Remidio Fundus on Phone.
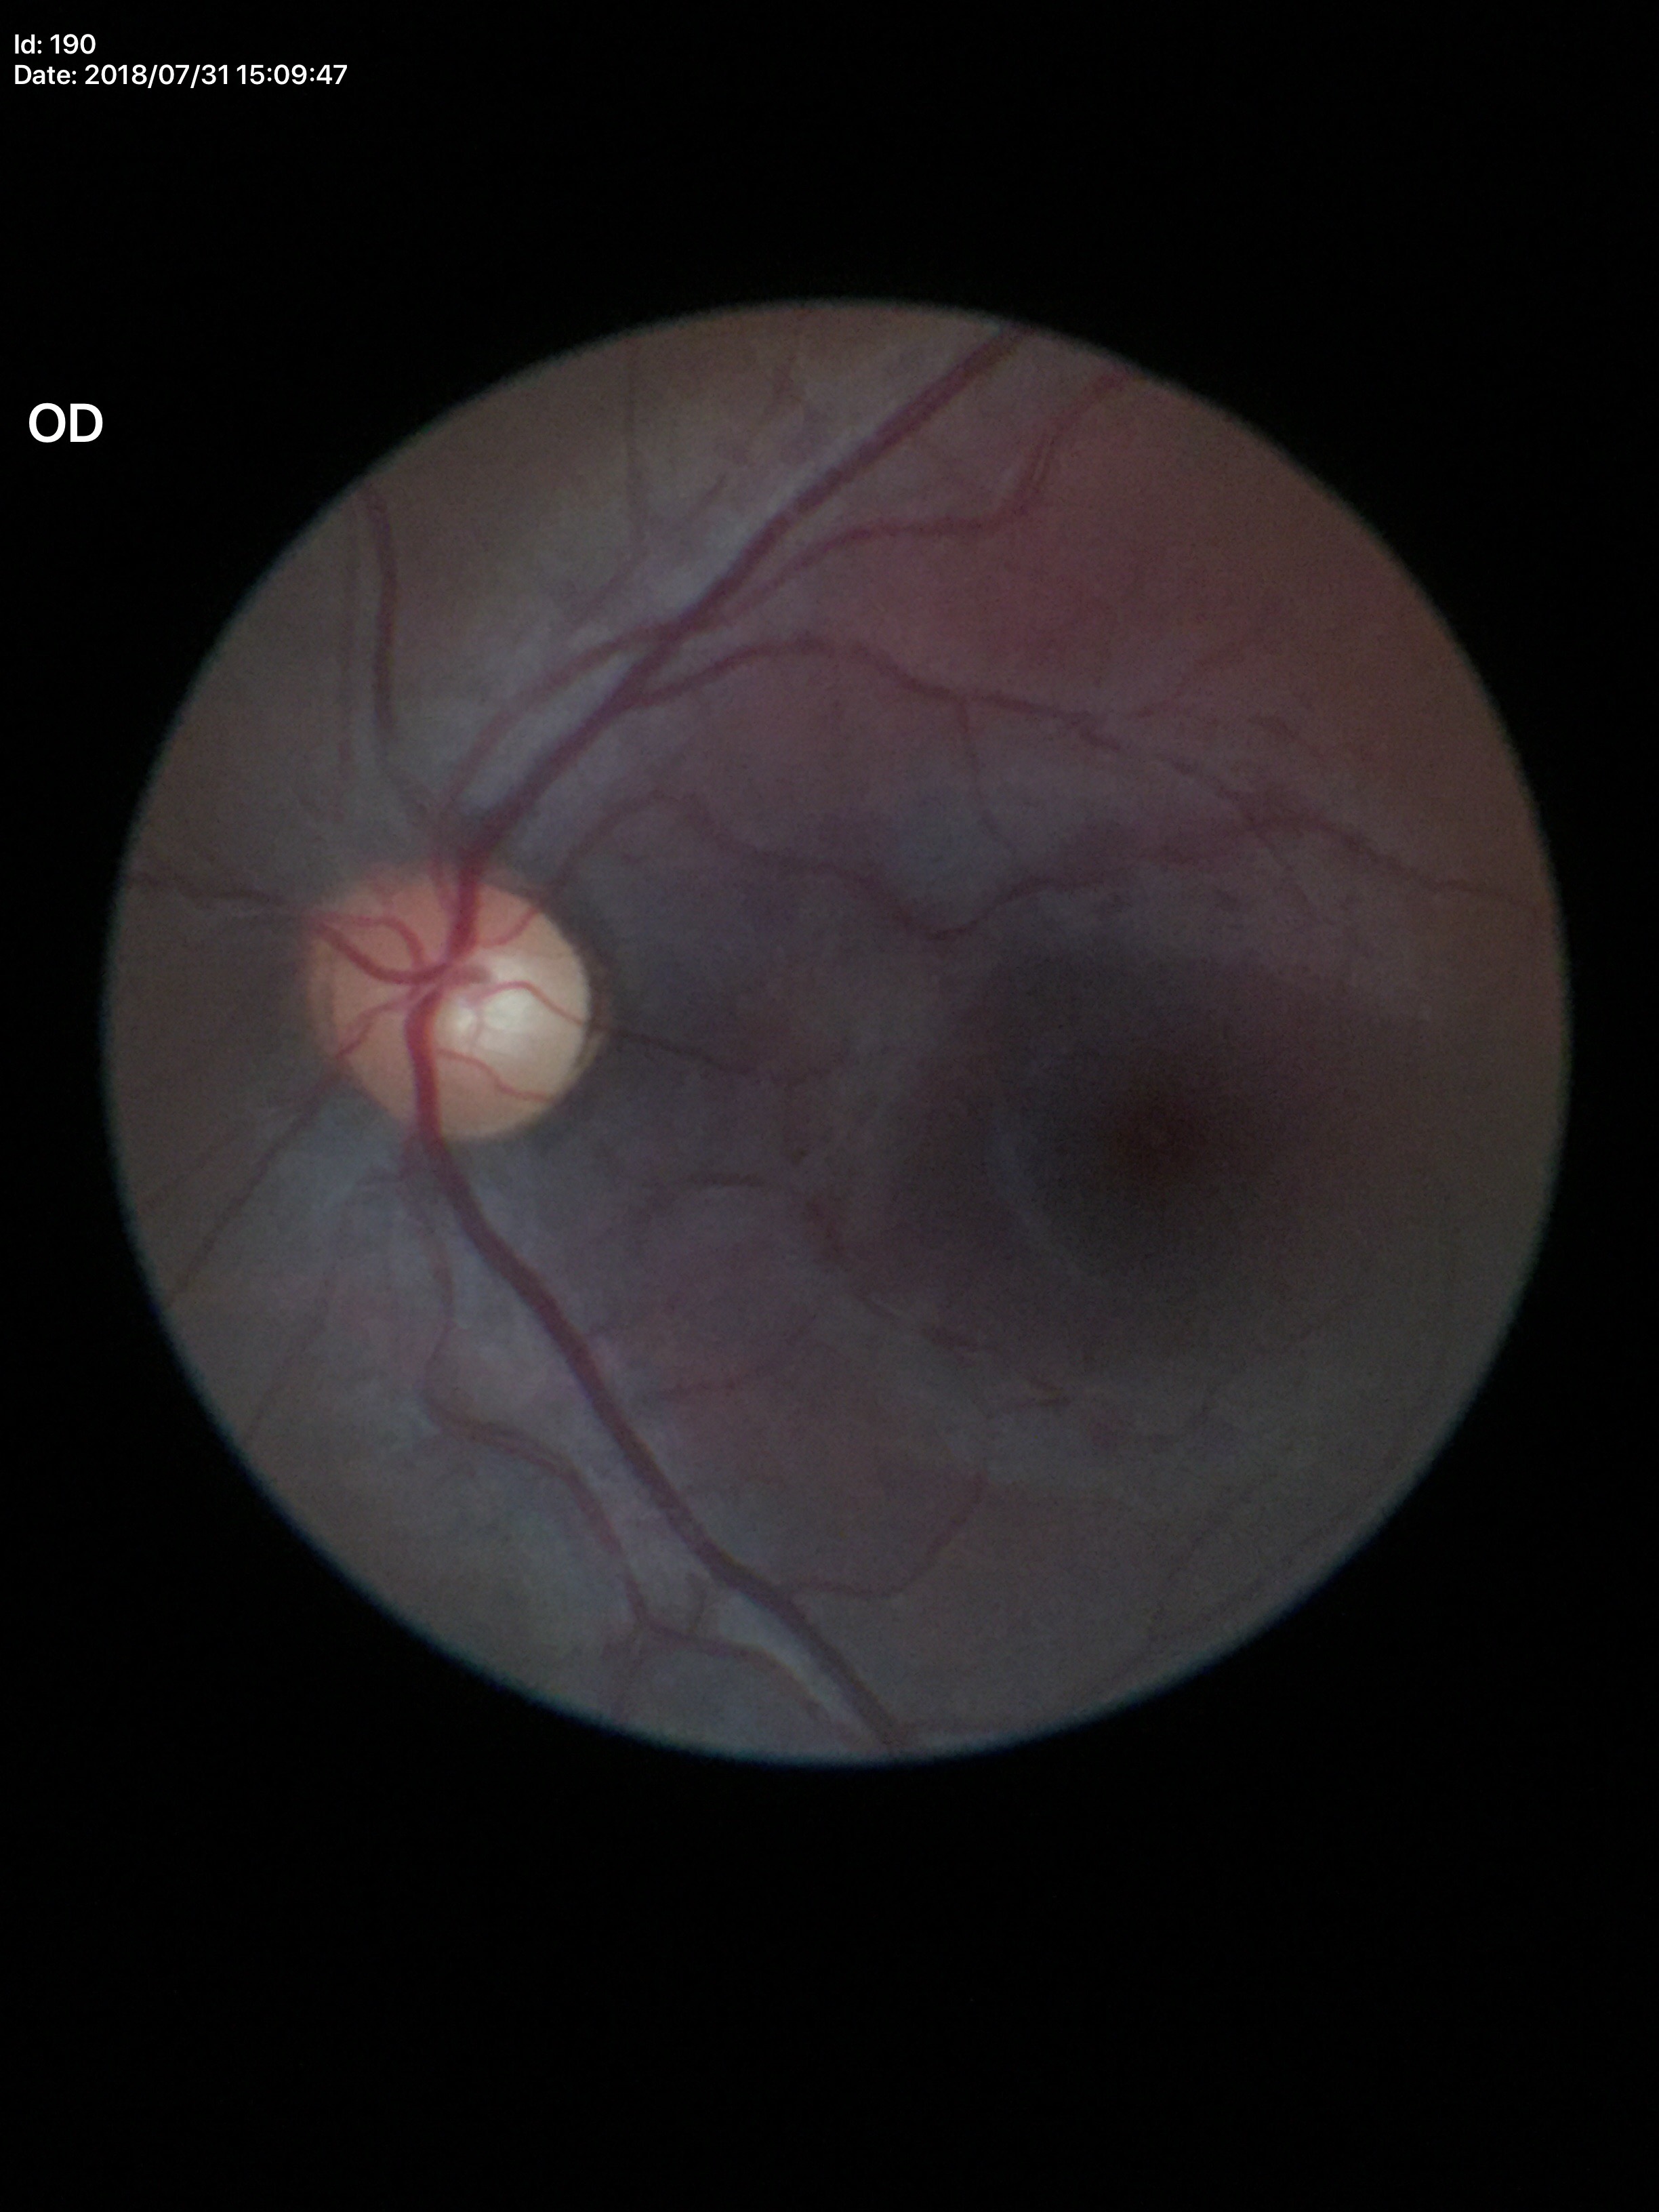 Glaucoma impression: negative | vertical C/D ratio: 0.54 | horizontal cup-disc ratio: 0.52.